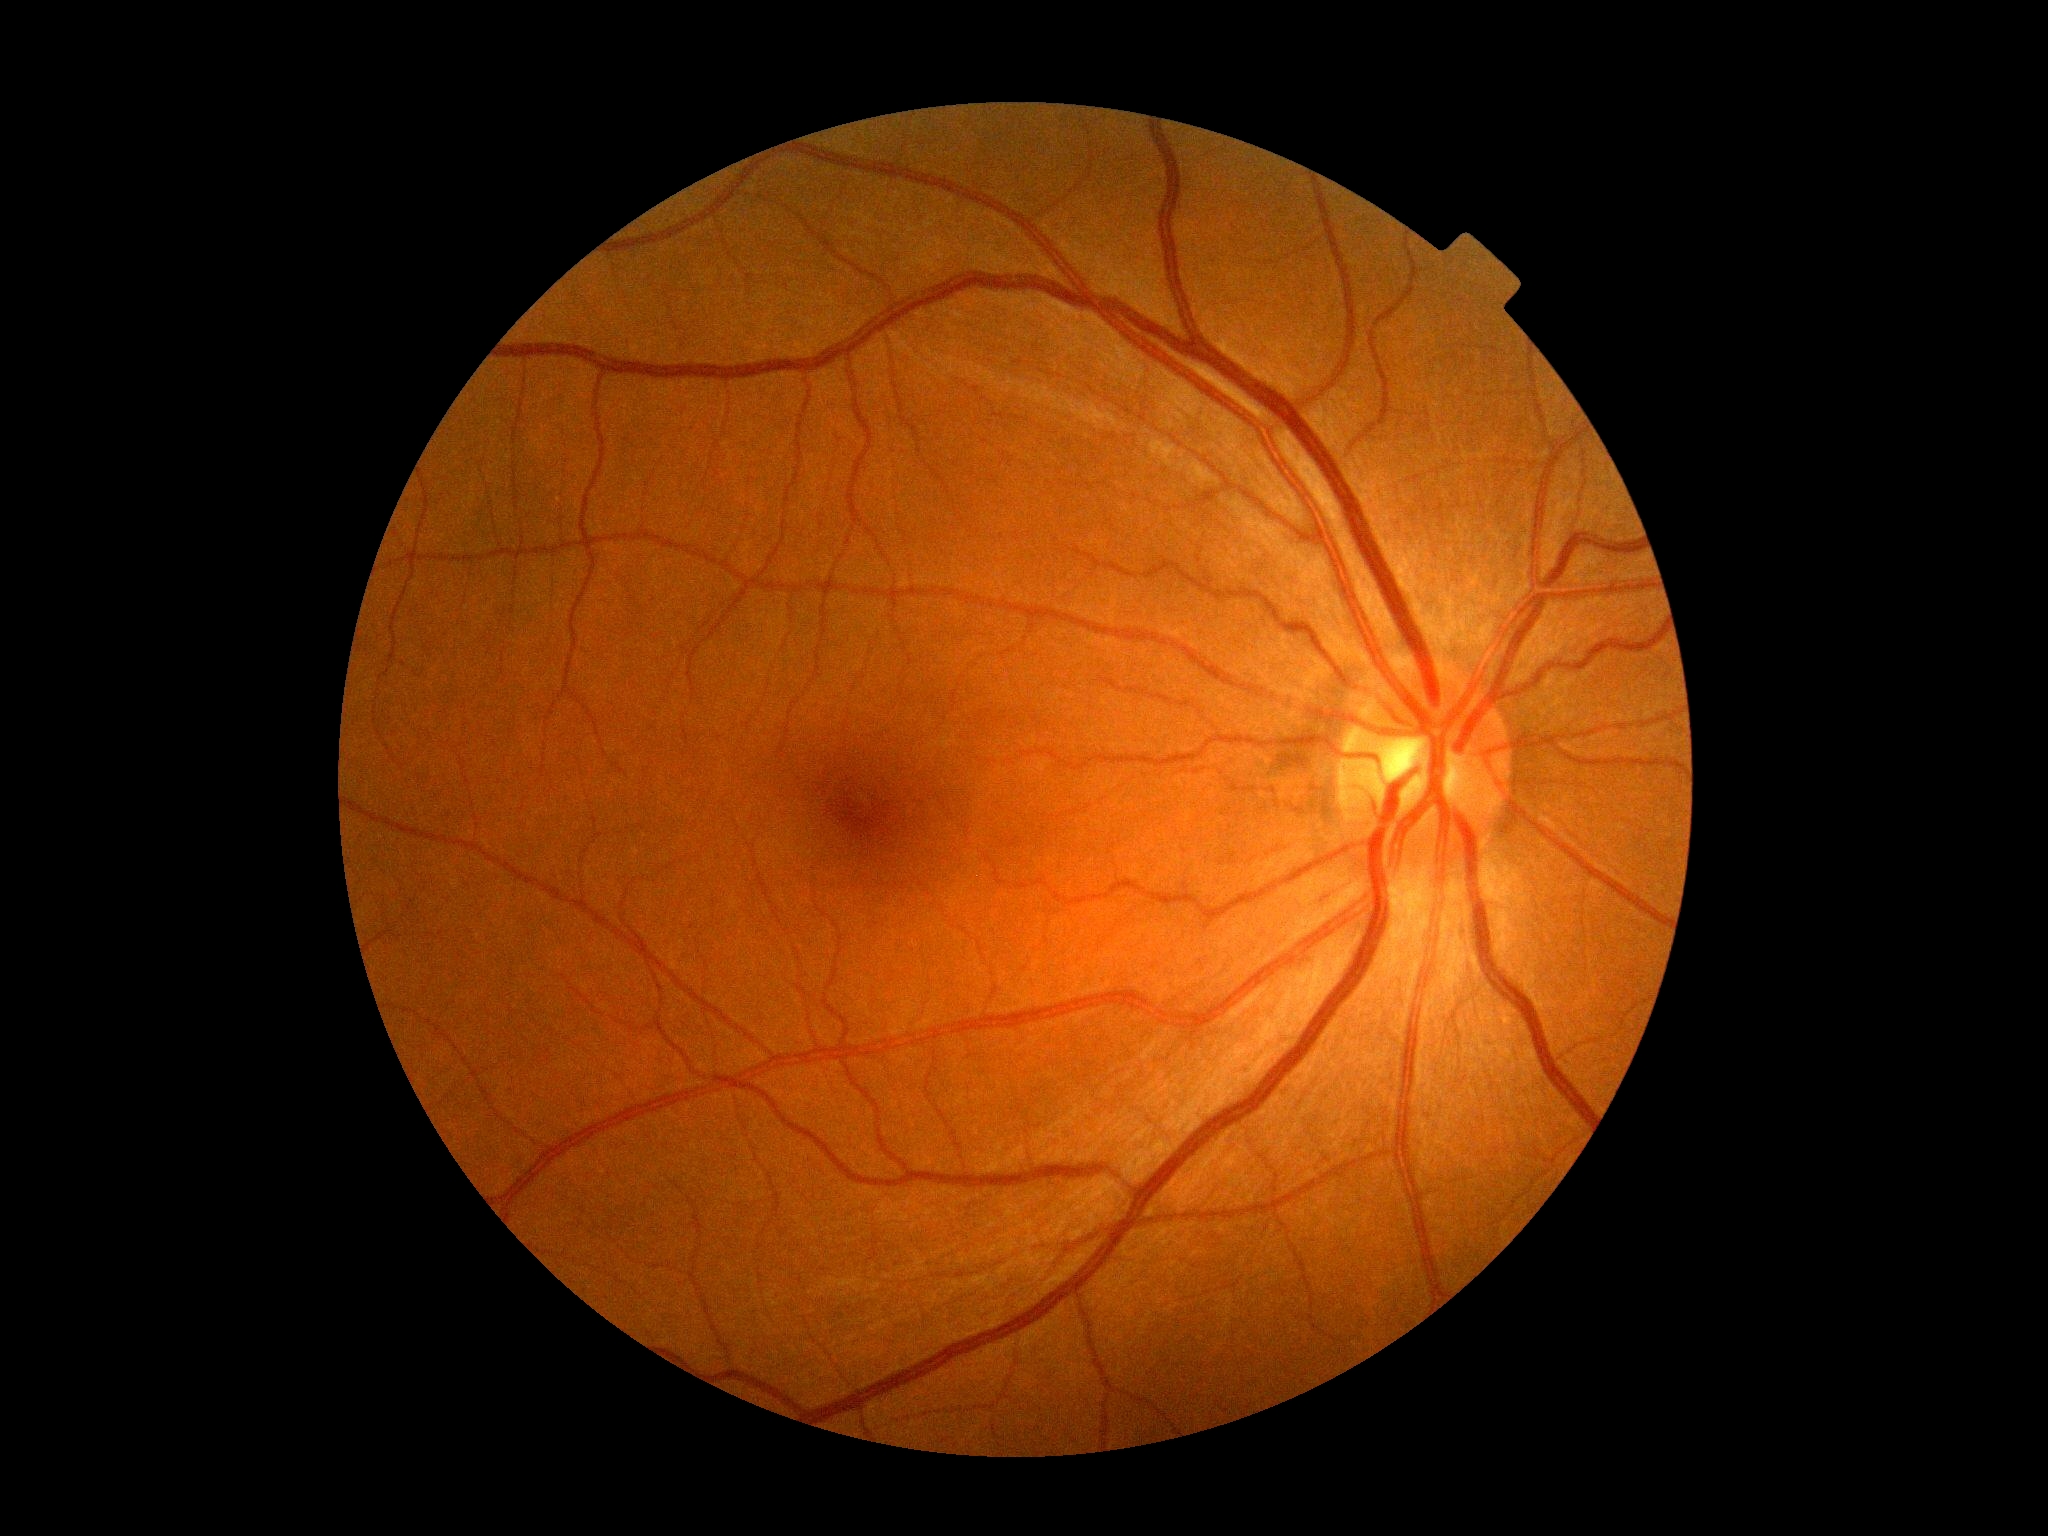 Findings:
* DR: grade 0 (no apparent retinopathy) — no visible signs of diabetic retinopathy